Retinal fundus photograph · non-mydriatic fundus camera: 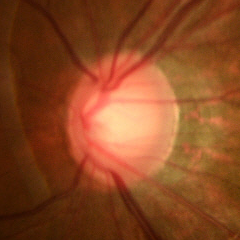

Early glaucomatous optic neuropathy.